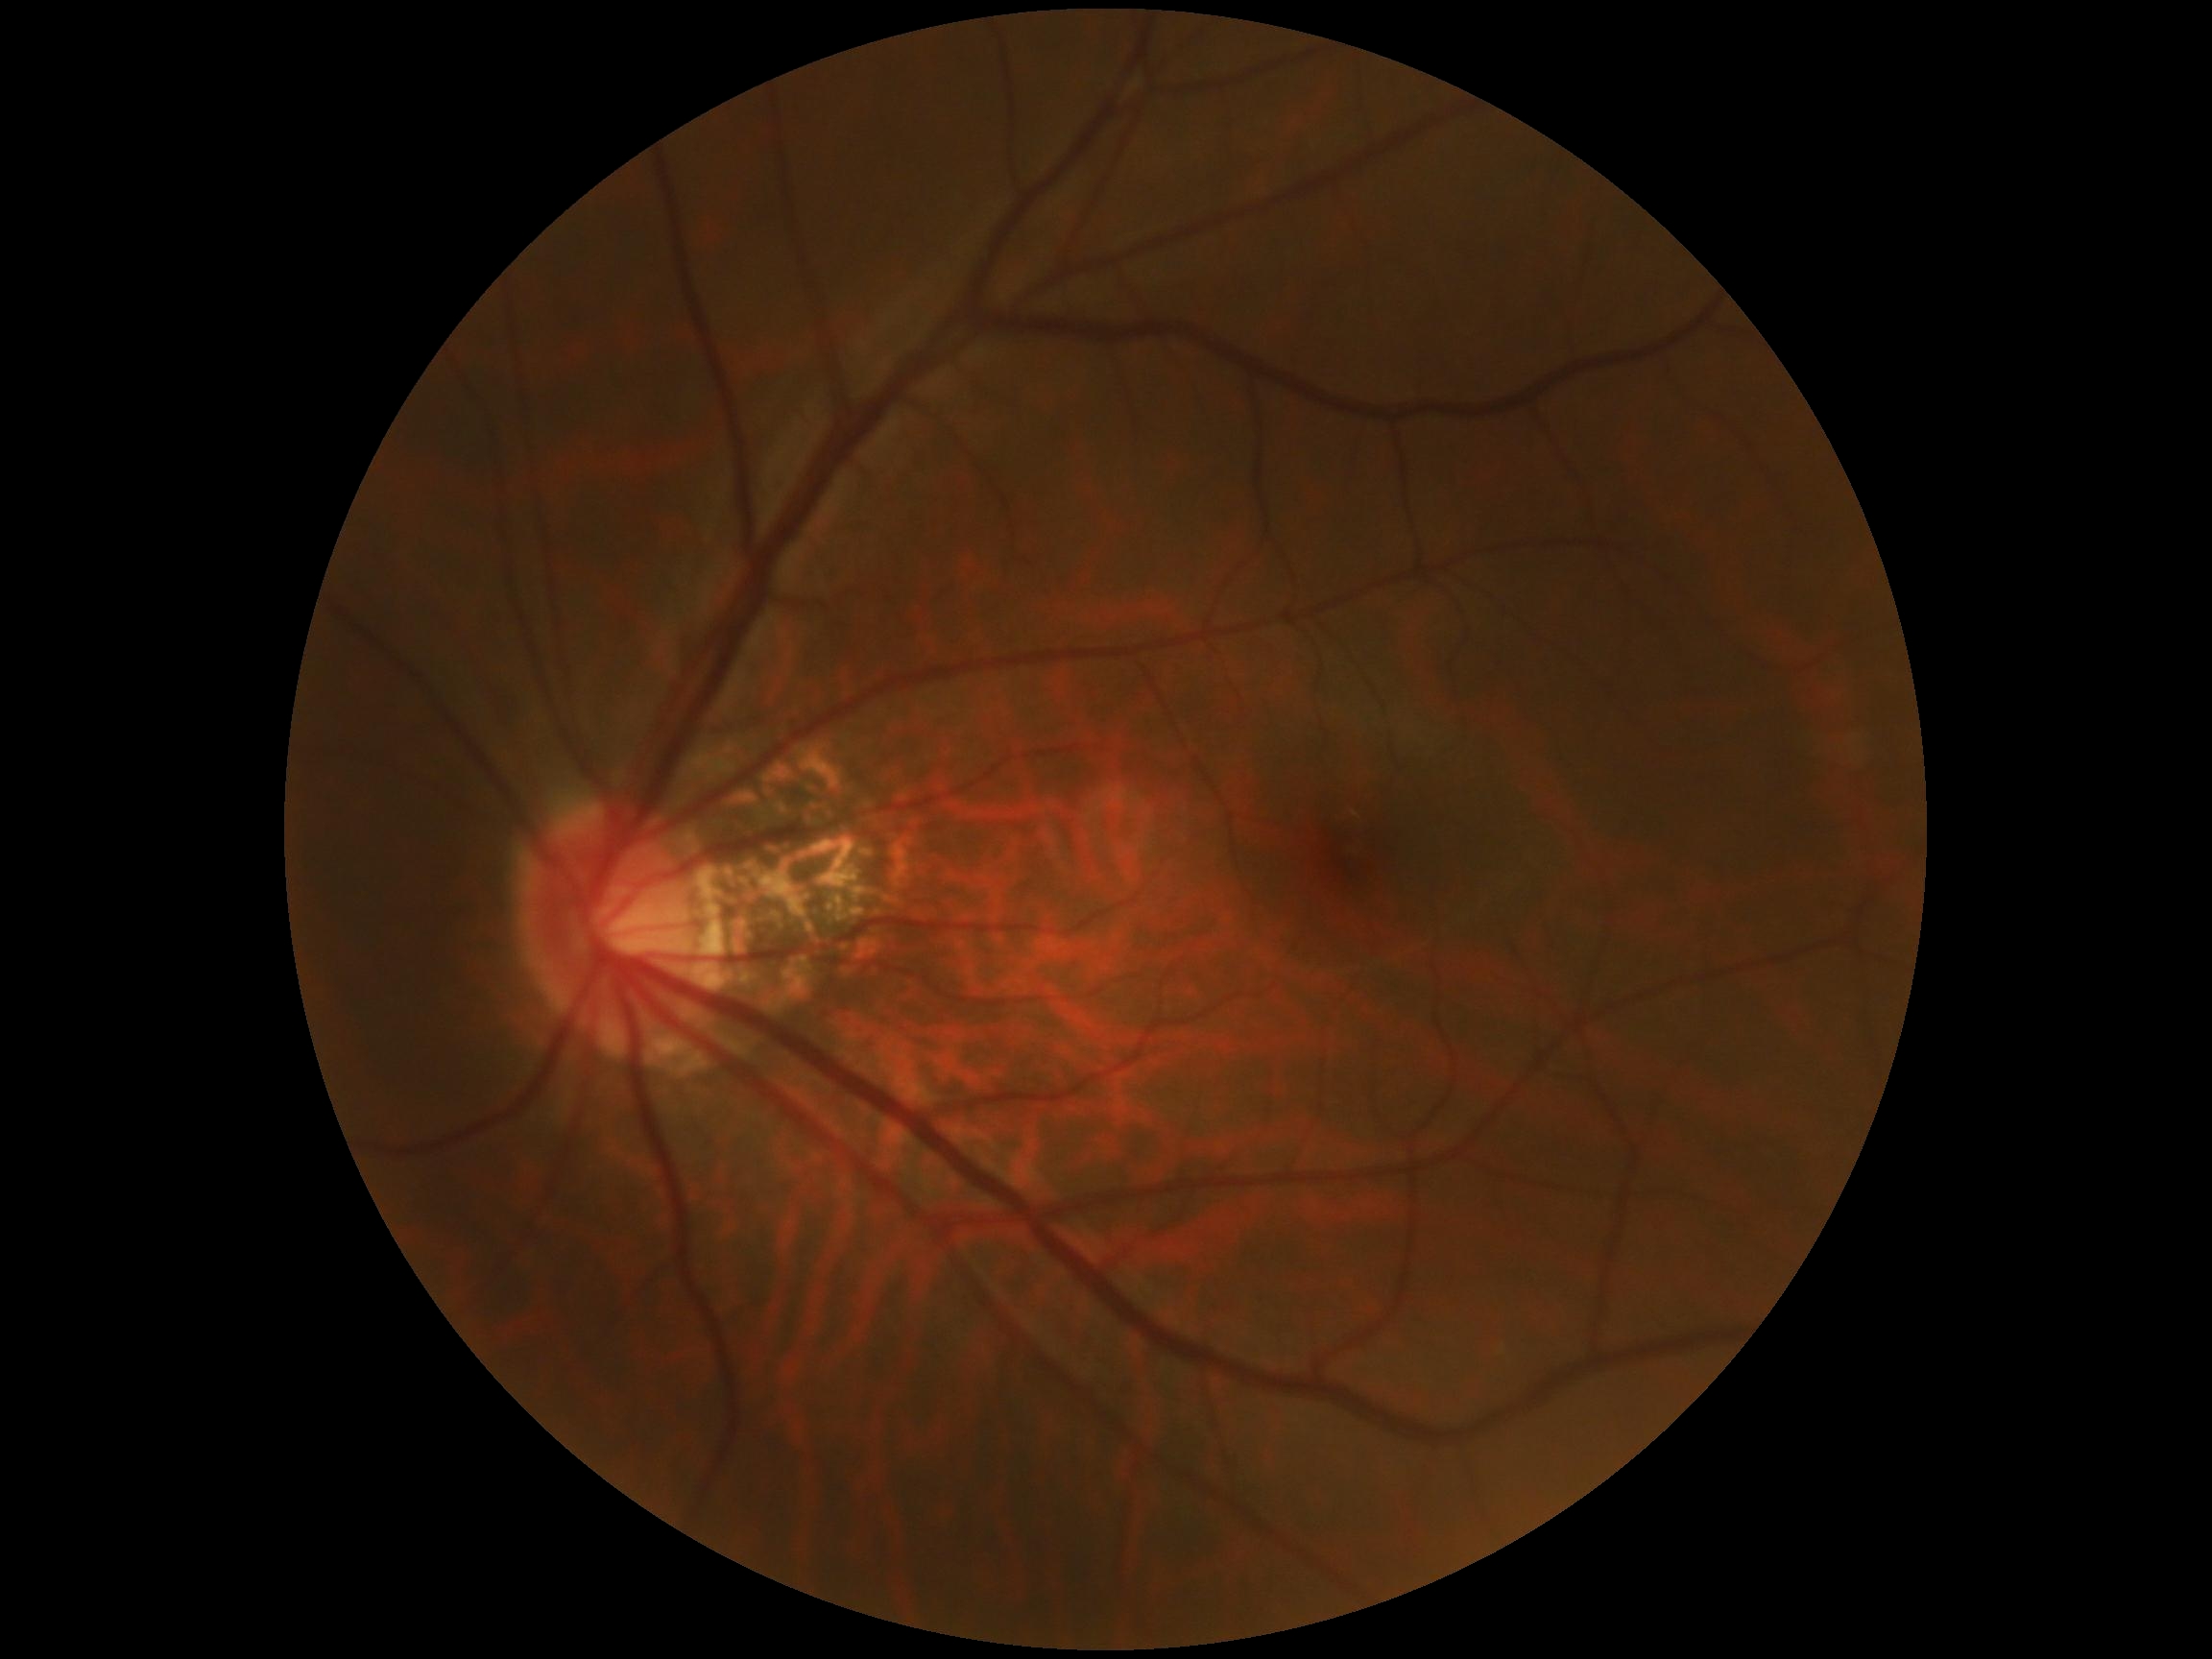   dr_impression: no apparent DR
  dr_grade: no apparent retinopathy (grade 0)